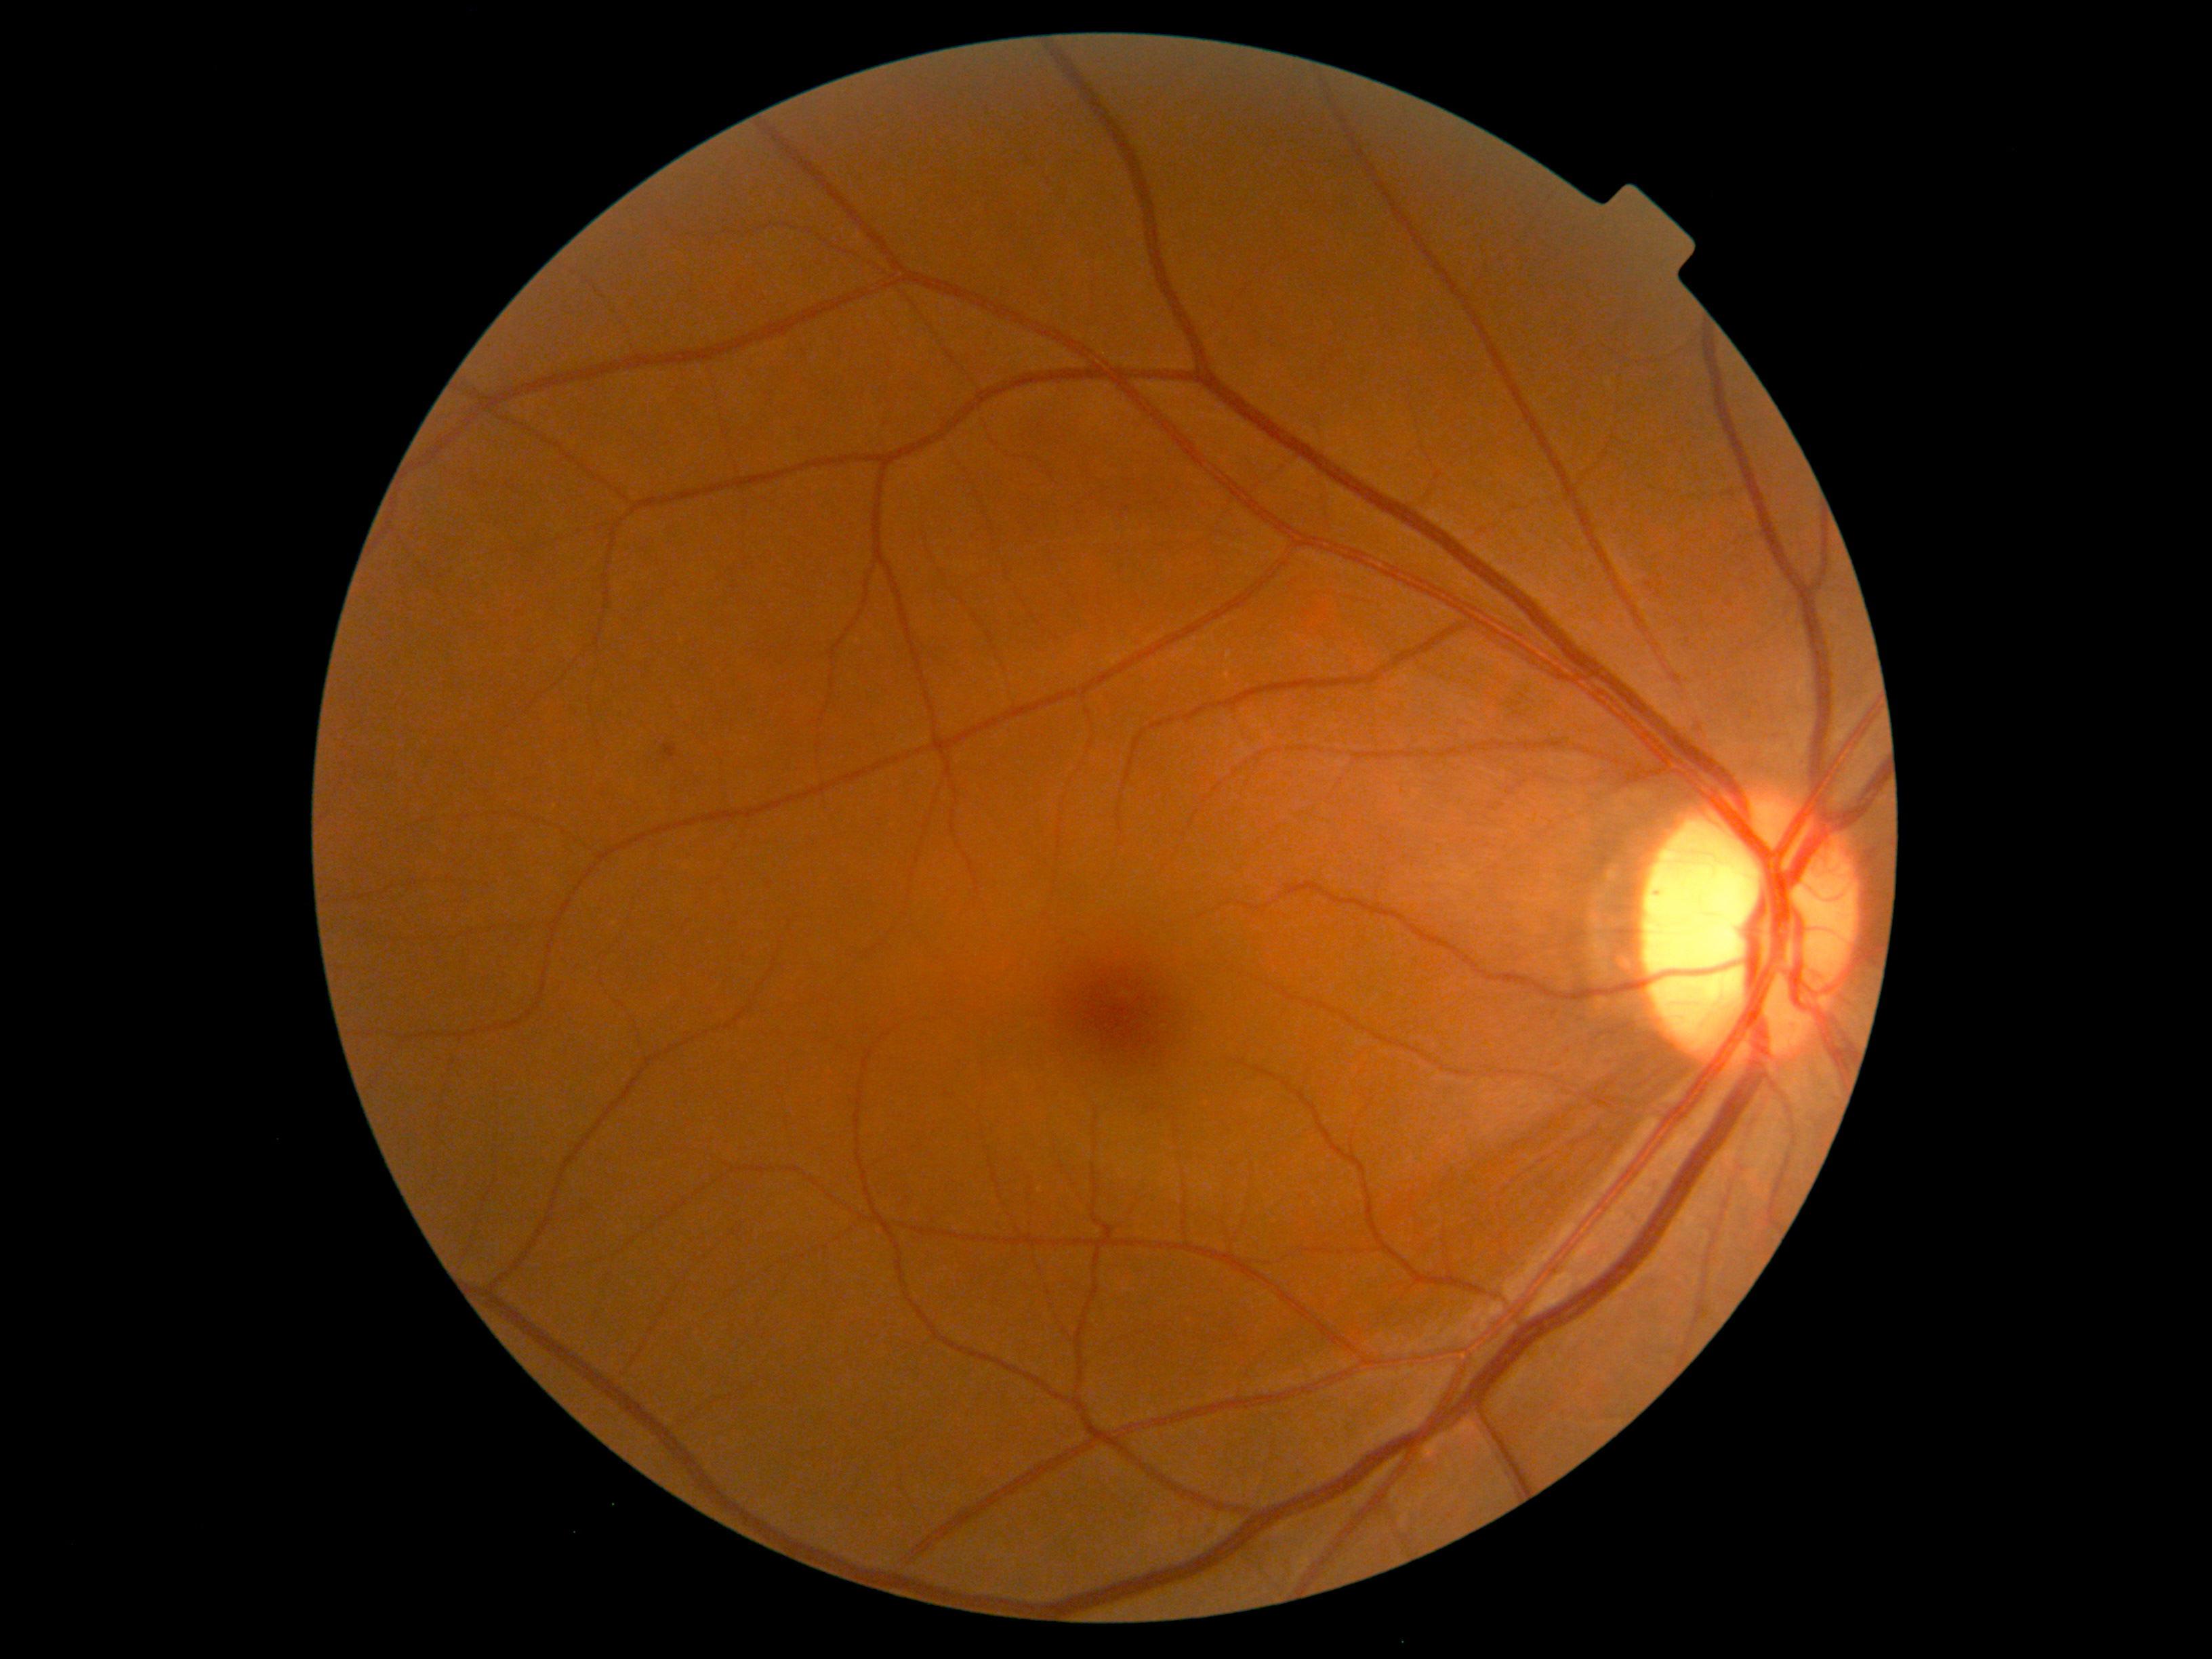

DR stage: grade 1 (mild NPDR) — presence of microaneurysms only.